100° field of view (Phoenix ICON); wide-field fundus image from infant ROP screening — 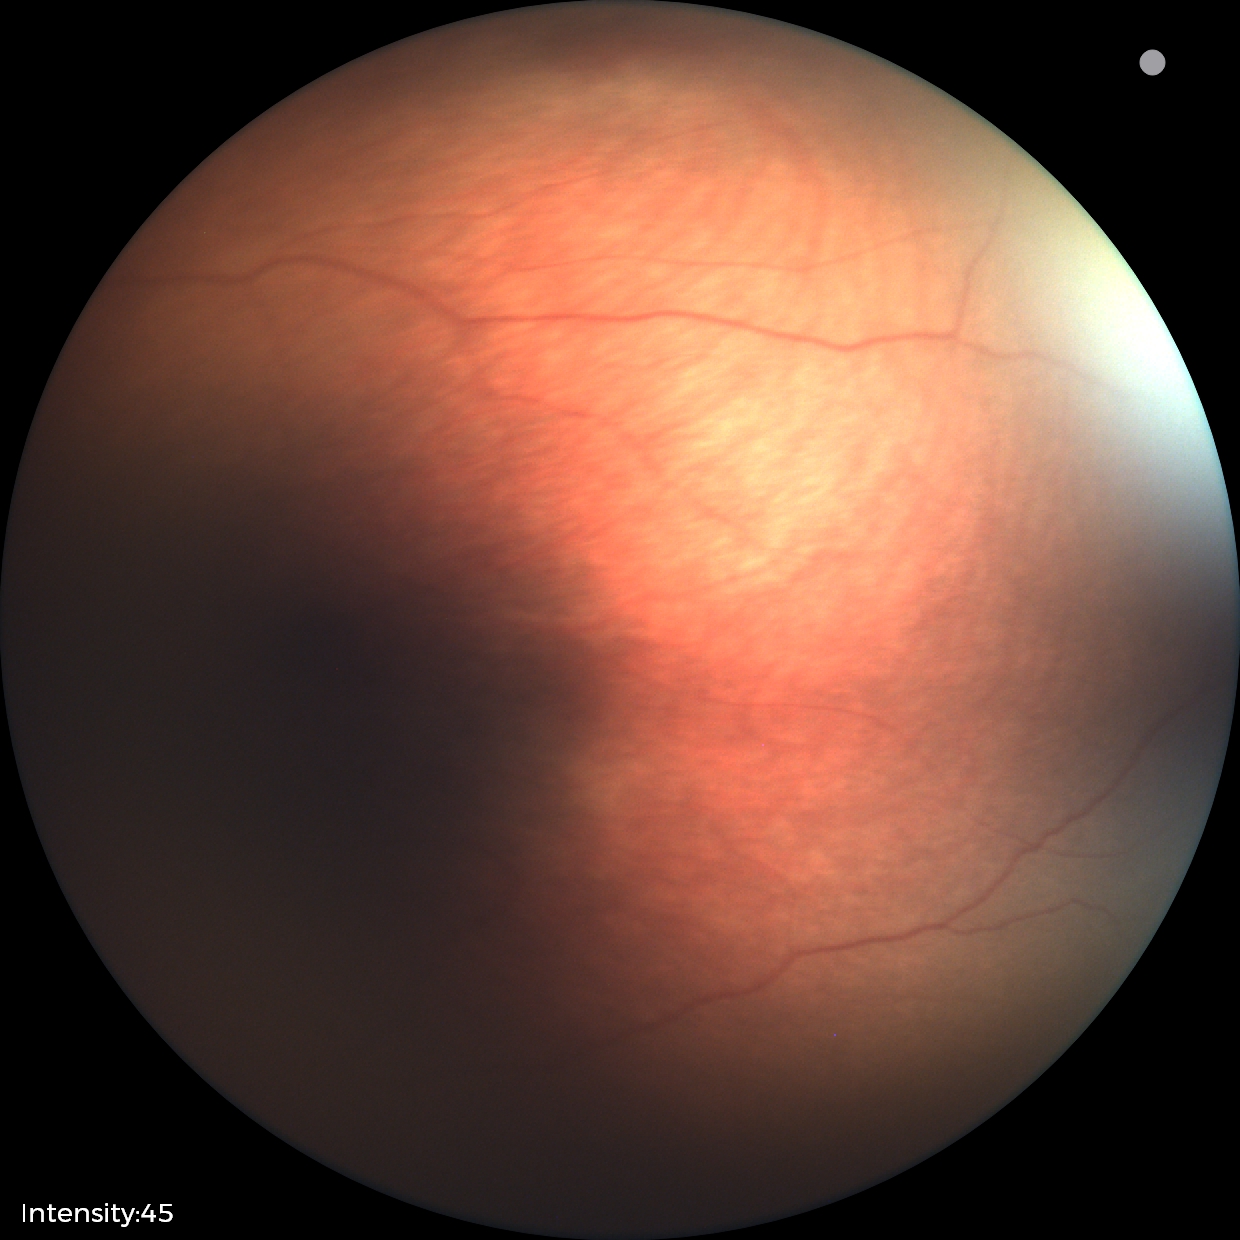 Screening examination with no abnormal retinal findings.